Without pupil dilation · acquired with a NIDEK AFC-230 · 848 by 848 pixels · 45° FOV · color fundus photograph:
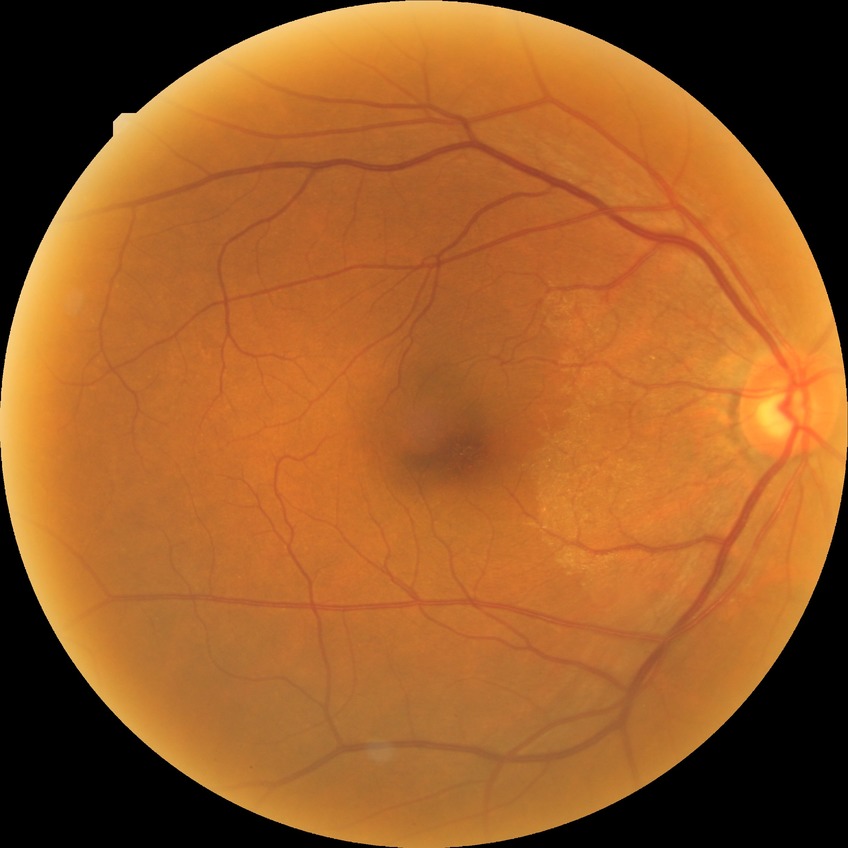

Retinopathy stage: no diabetic retinopathy.